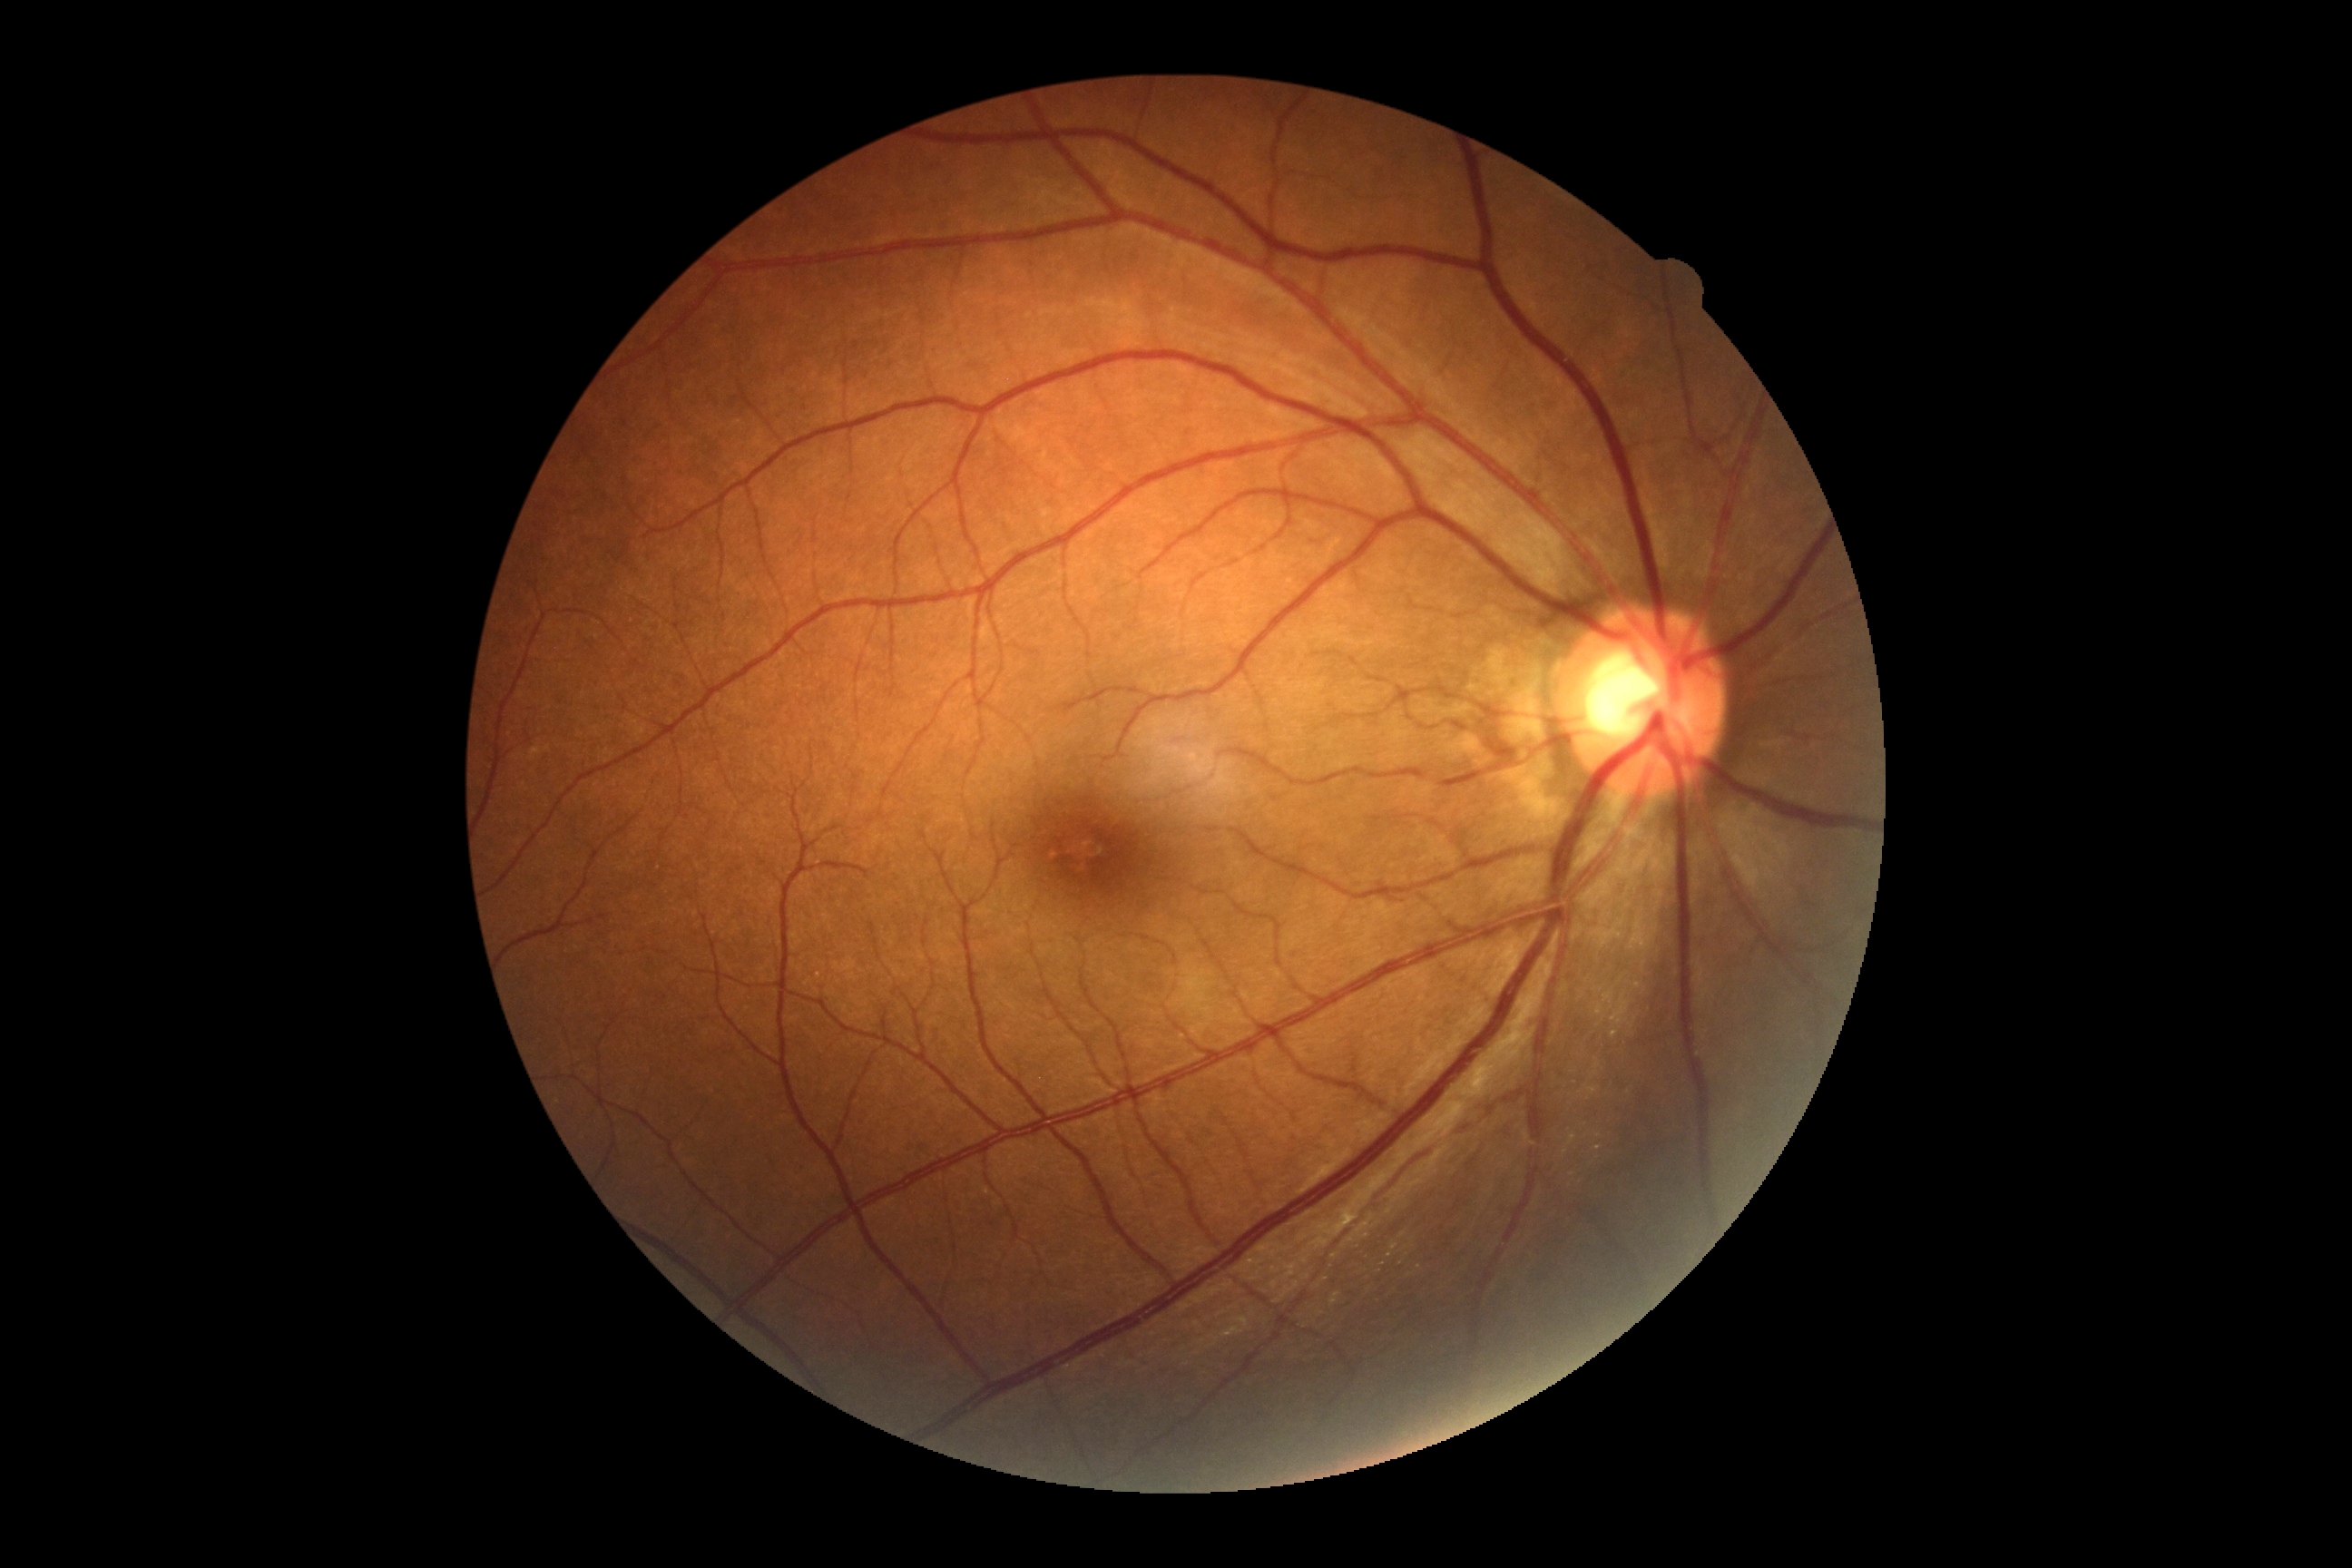

DR: 0/4.